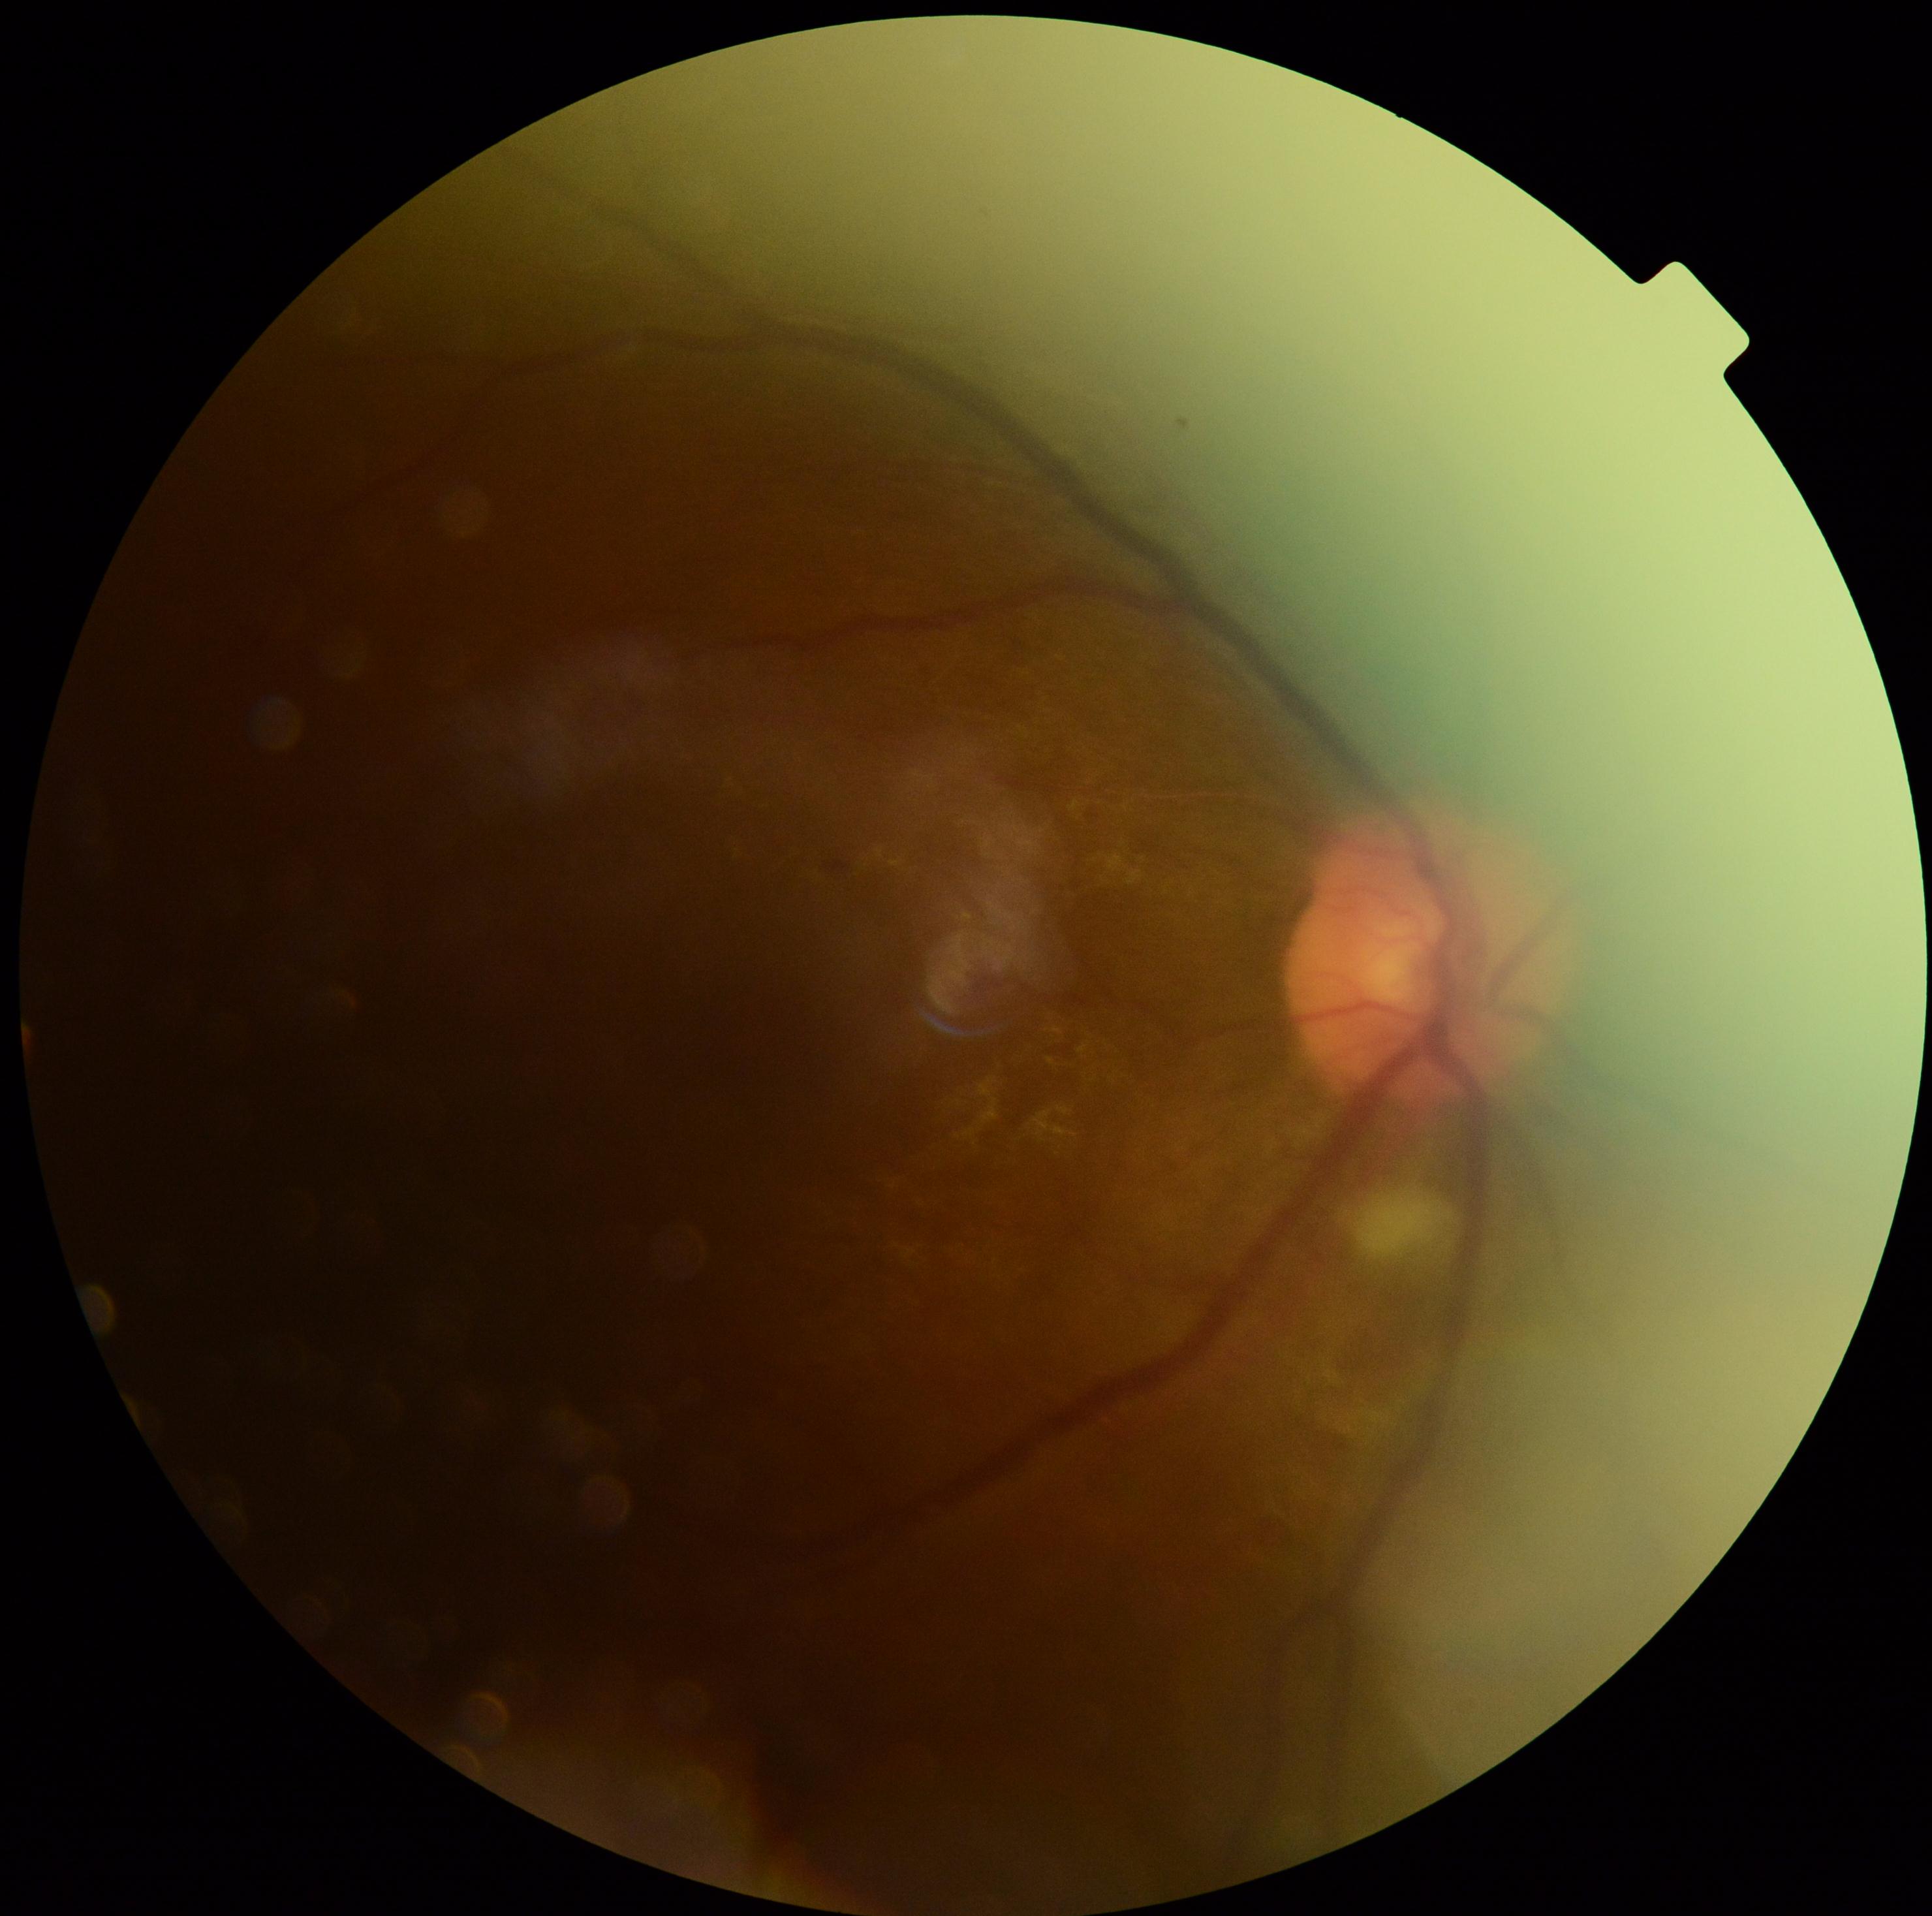 DR class = non-proliferative diabetic retinopathy
diabetic retinopathy (DR) = moderate non-proliferative diabetic retinopathy (grade 2)